Without pupil dilation; CFP; camera: NIDEK AFC-230; 45-degree field of view: 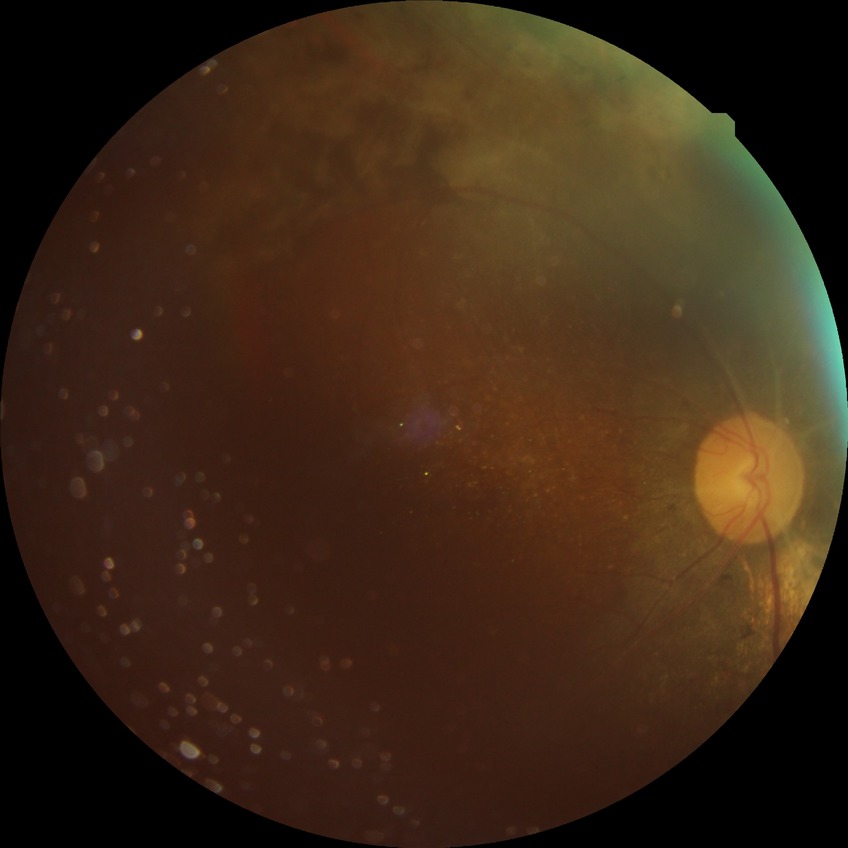   davis_grade: proliferative diabetic retinopathy